Image size 1440x1080; pediatric wide-field fundus photograph; 130° field of view (Natus RetCam Envision):
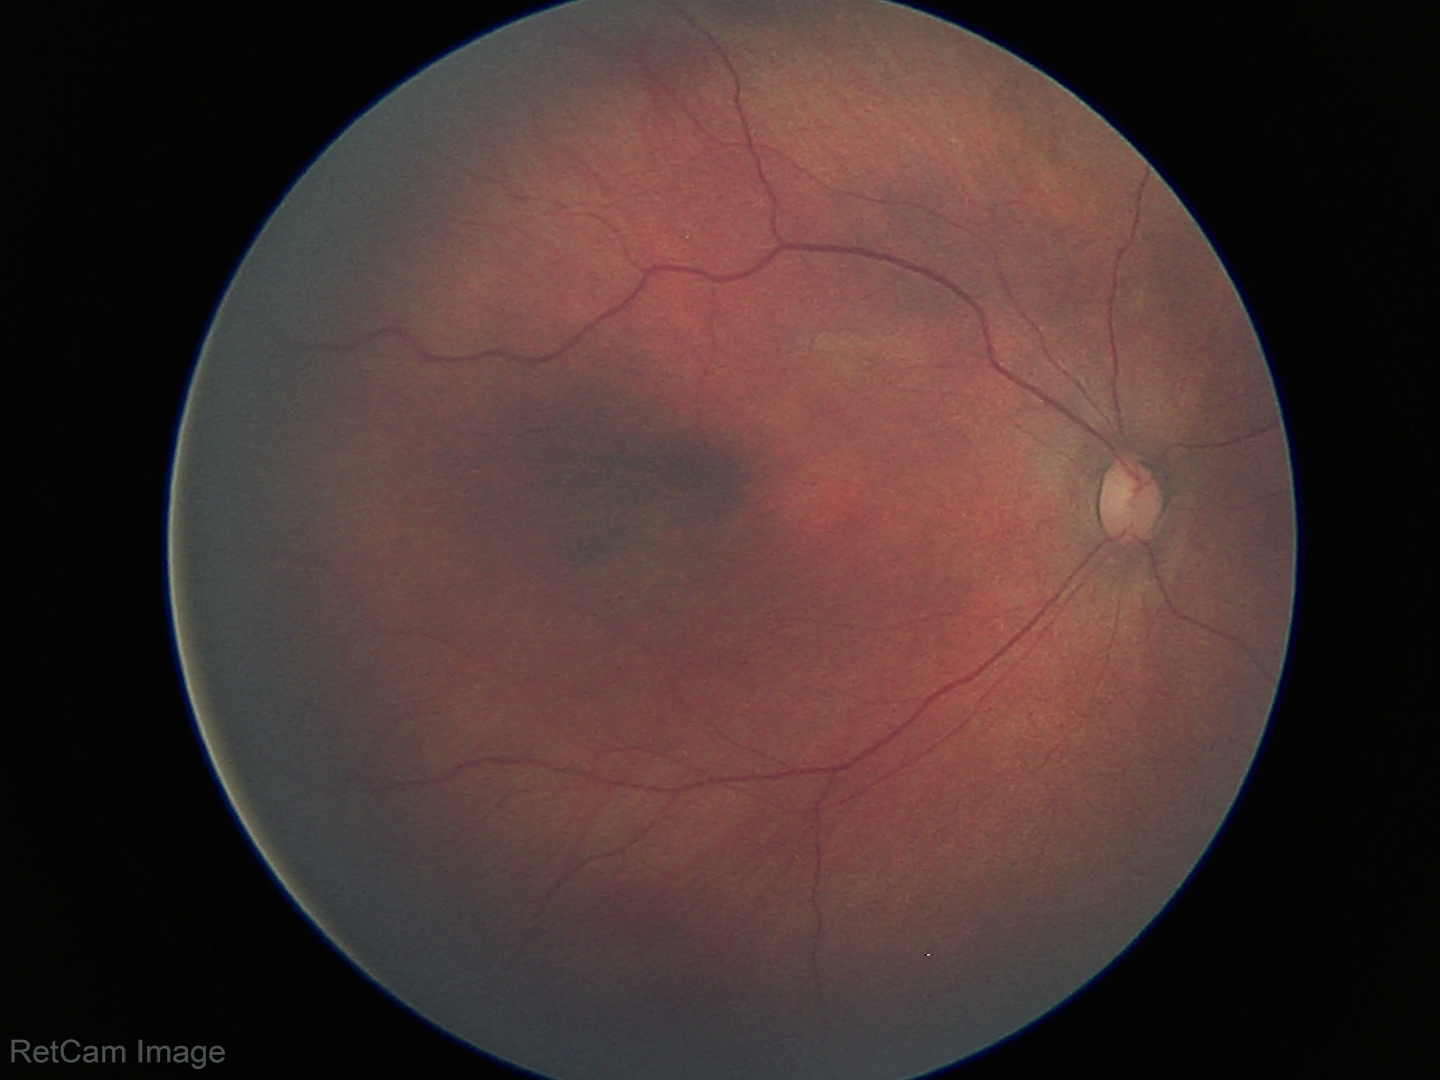
Assessment = no abnormalities